Camera: NIDEK AFC-230 · image size 848x848 · 45° field of view: 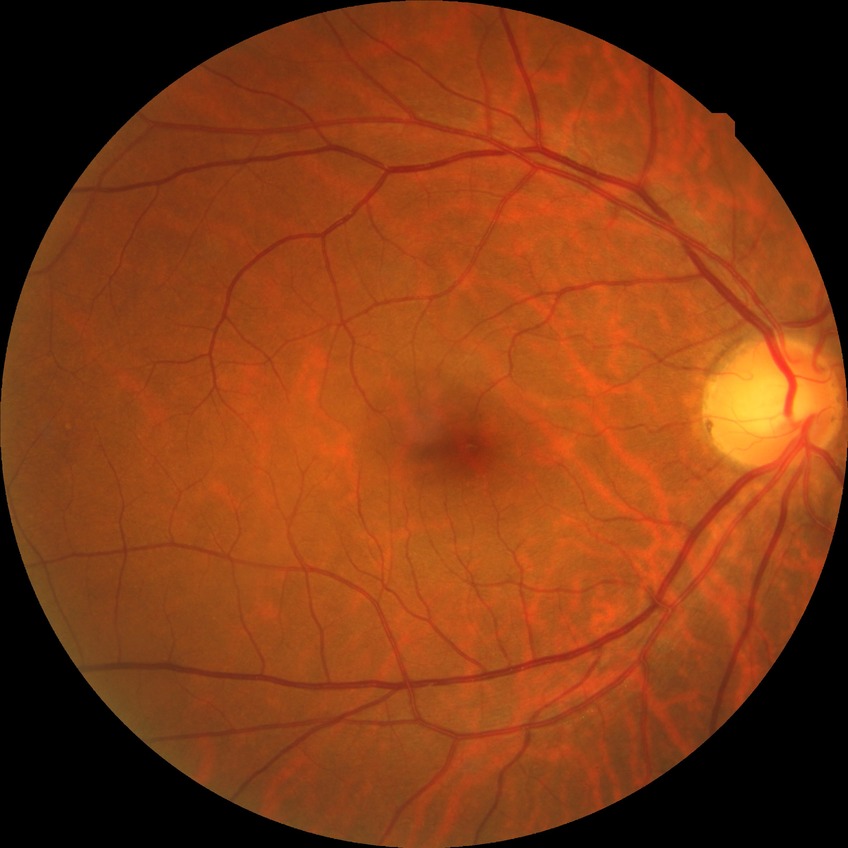

DR stage = NDR; DR impression = no apparent DR.